Retinal fundus photograph.
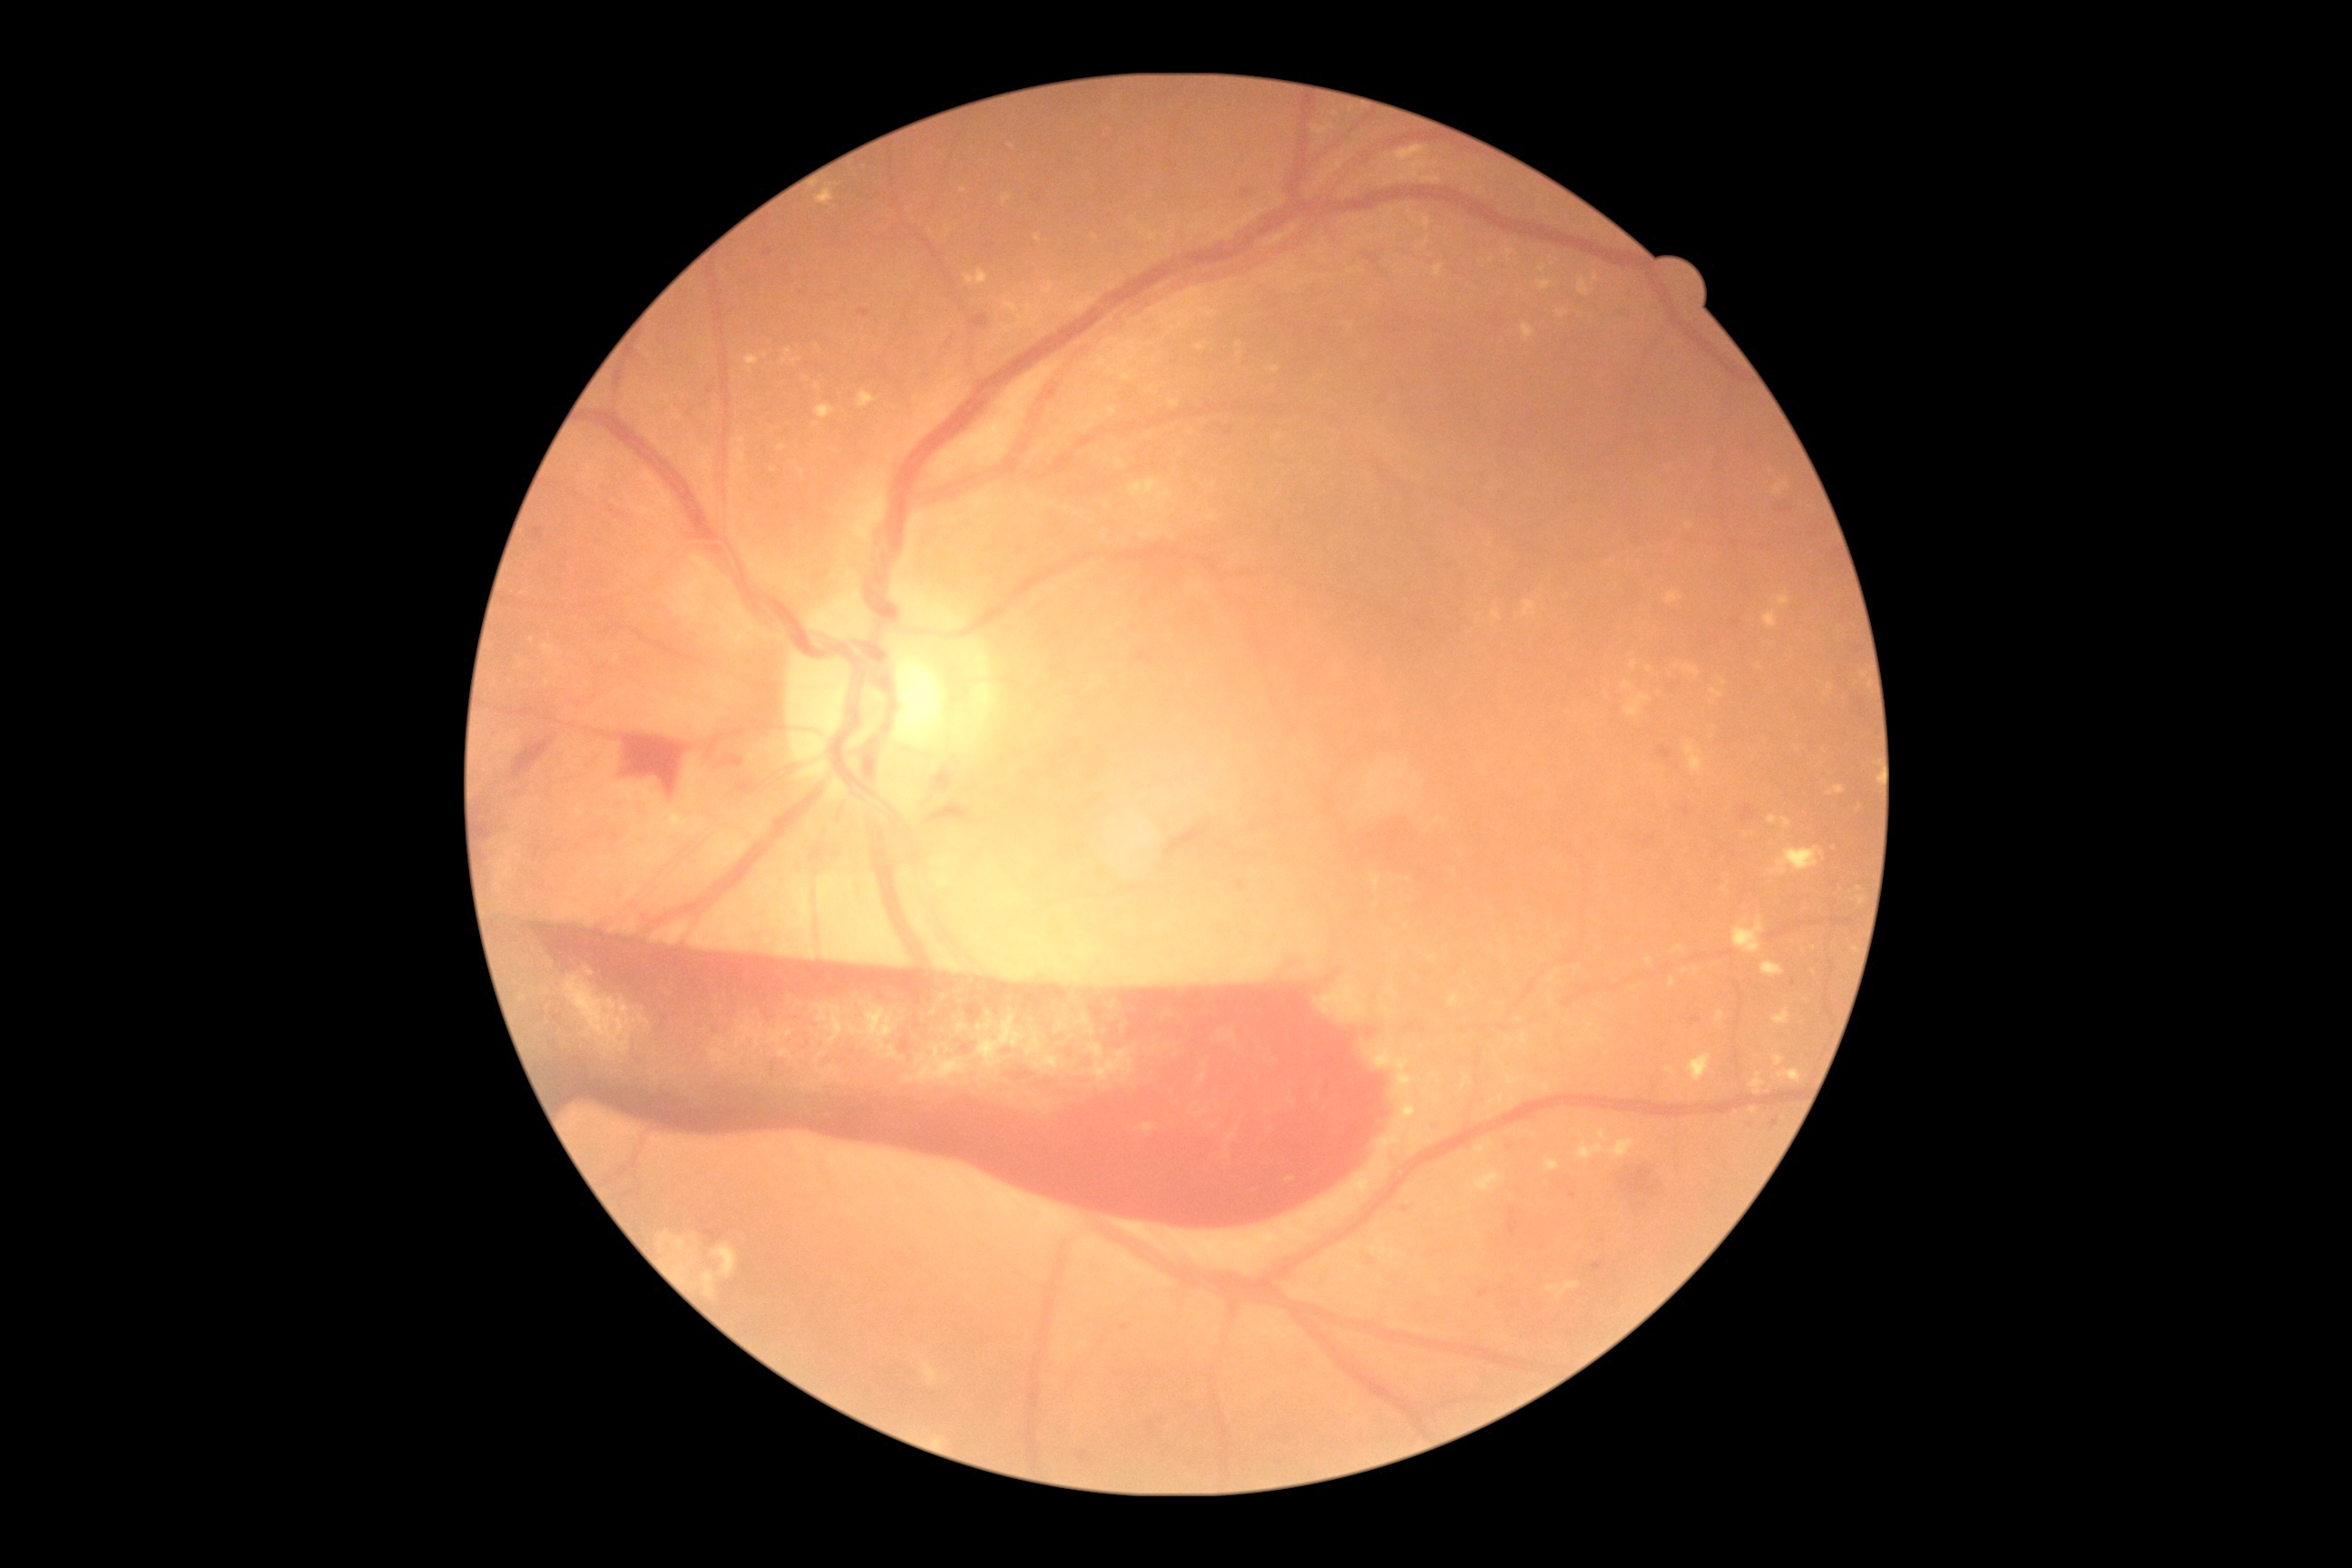
Retinopathy: grade 4.
Disease class: proliferative diabetic retinopathy.